Fundus photo; 2352 x 1568 pixels.
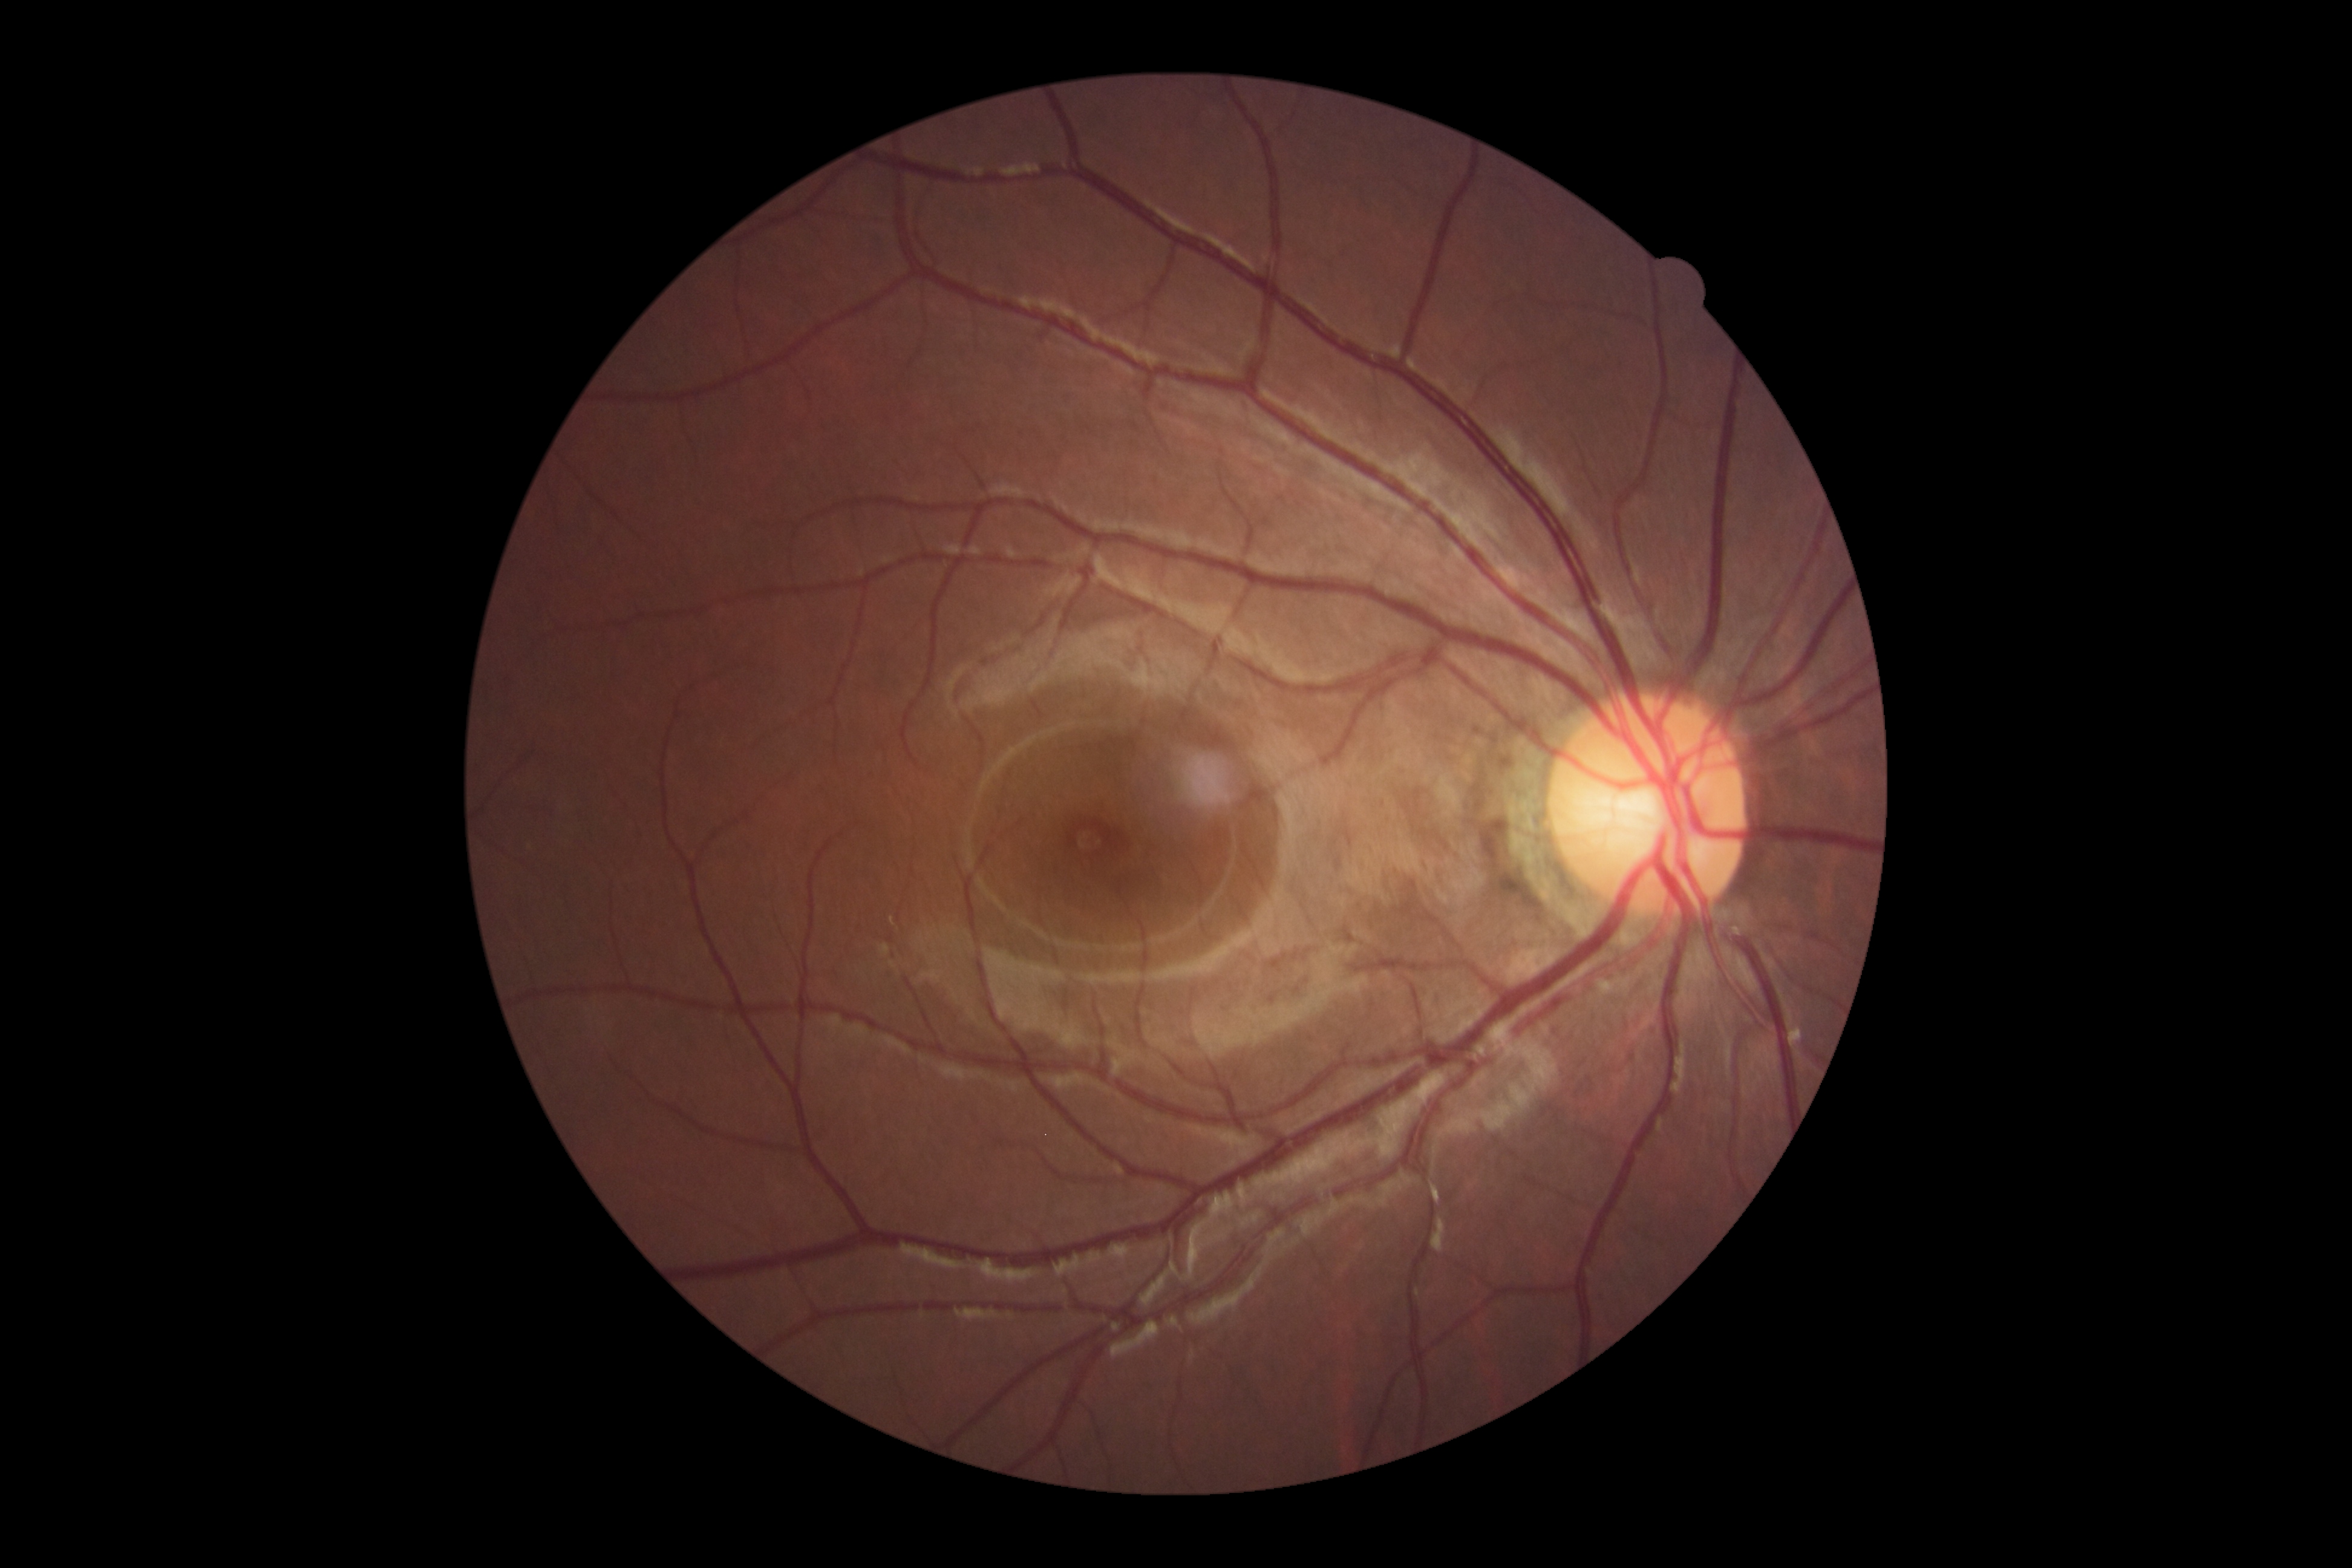
No DR findings.
DR severity: grade 0 — no visible signs of diabetic retinopathy.